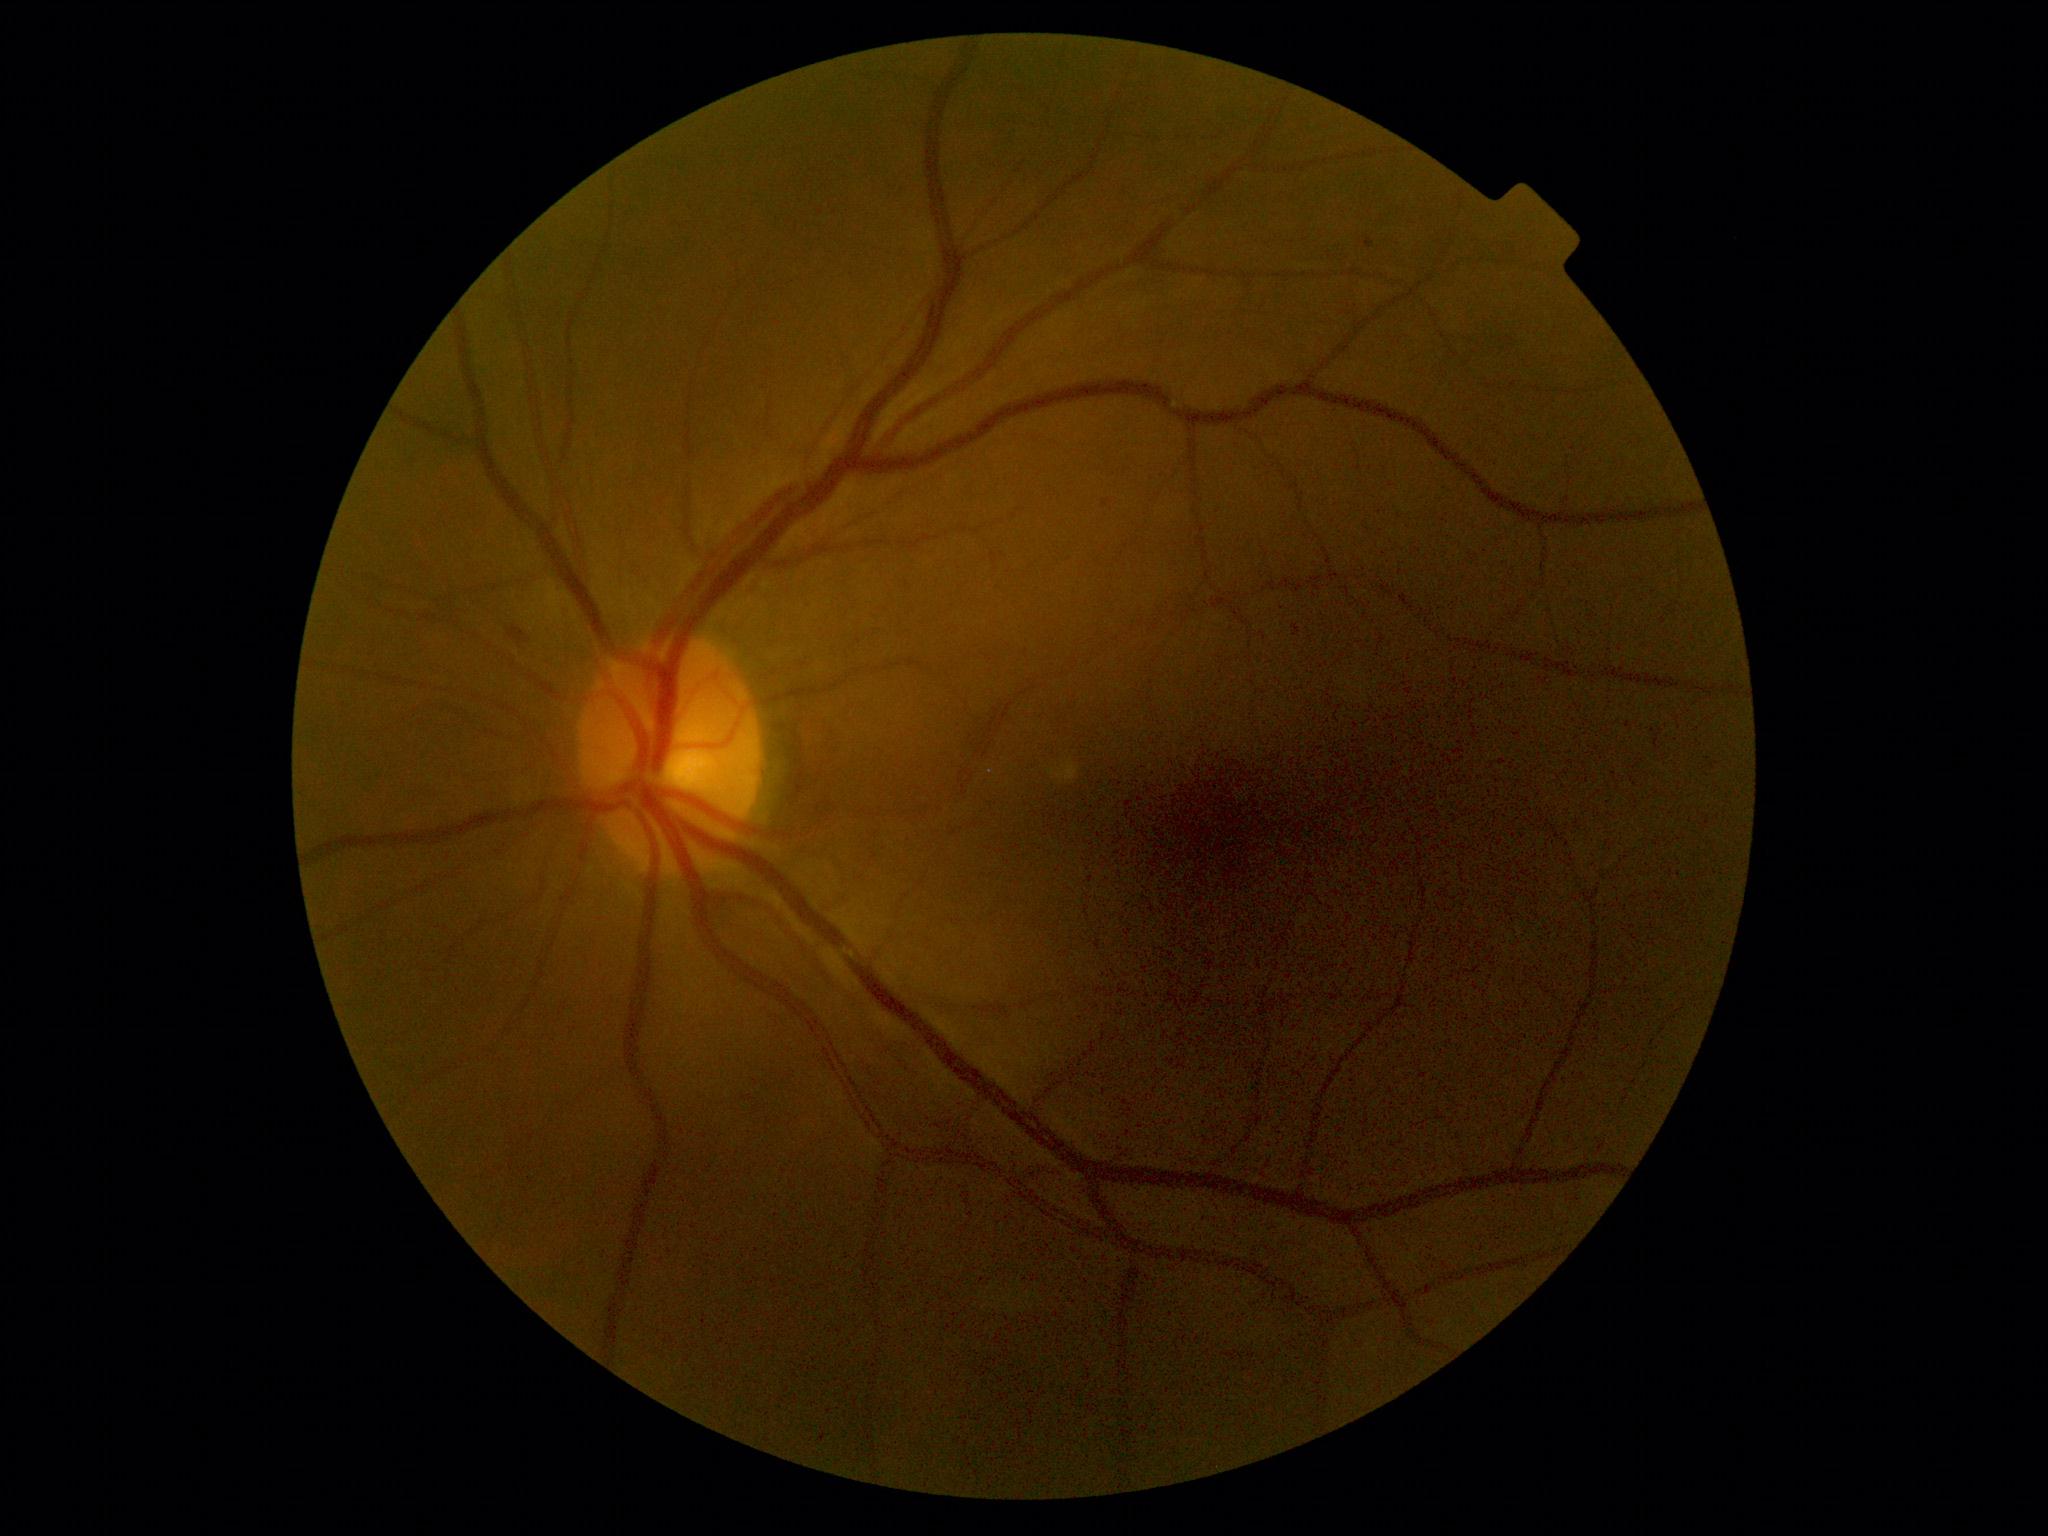

The retinopathy is classified as non-proliferative diabetic retinopathy.
Diabetic retinopathy (DR): grade 2 (moderate NPDR).